Fundus photo. 45-degree field of view — 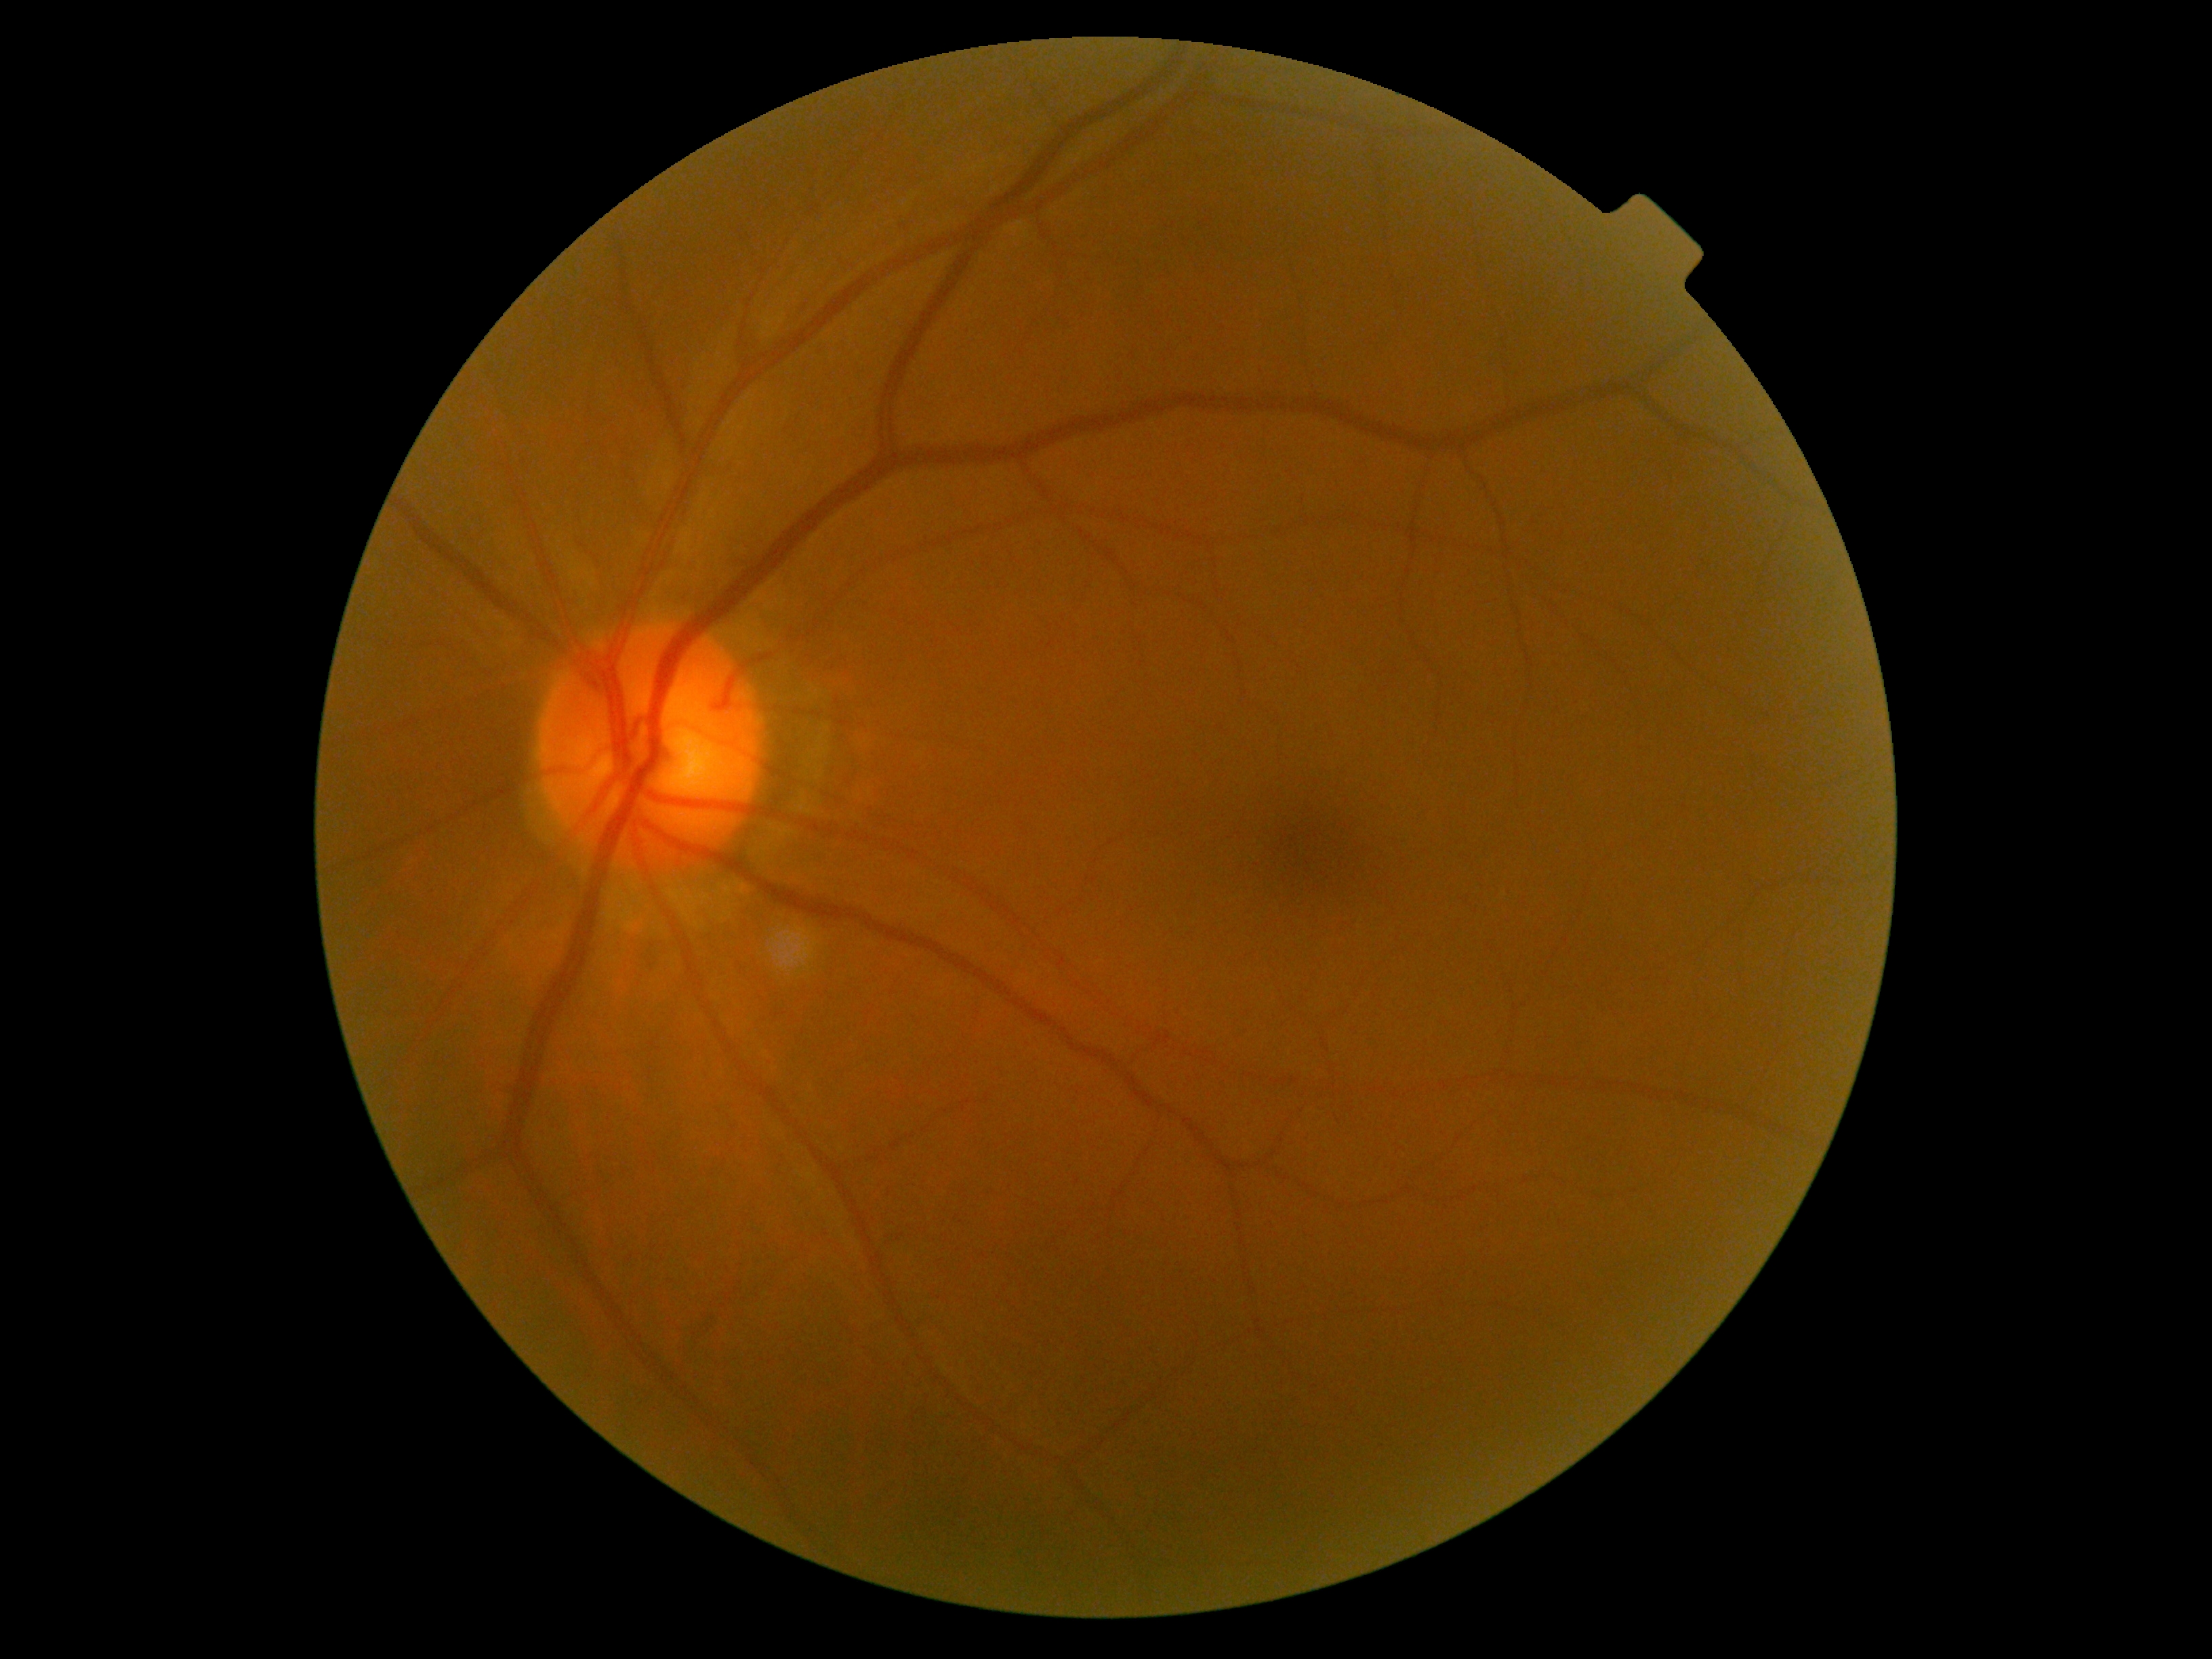 diabetic retinopathy (DR): grade 0 (no apparent retinopathy).